Modified Davis grading, without pupil dilation, 45° FOV — 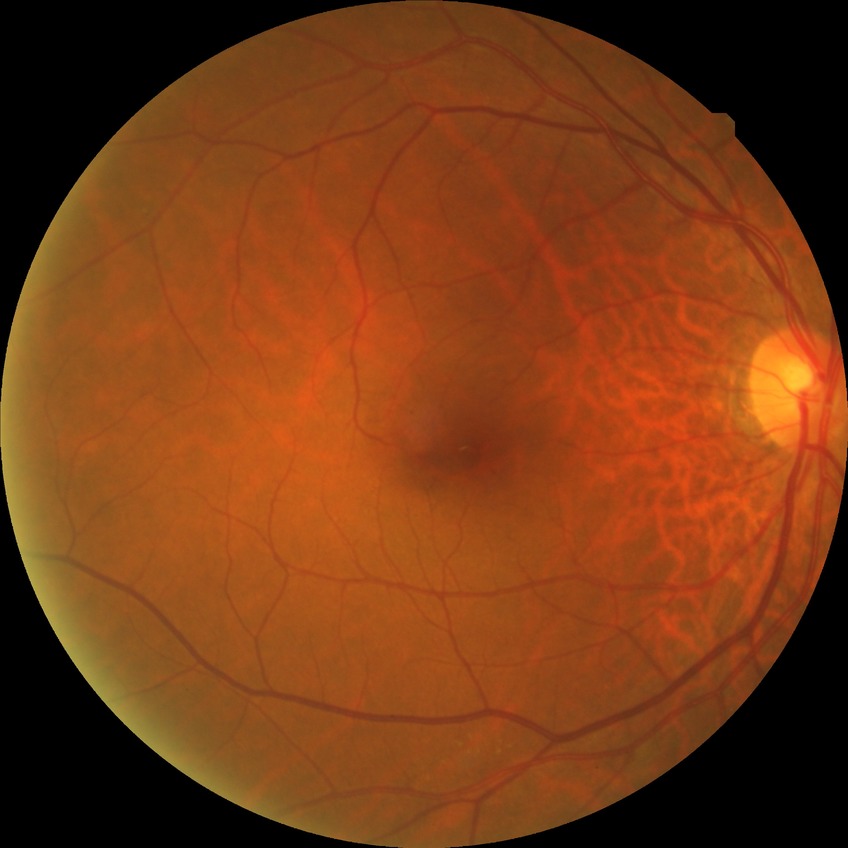
diabetic retinopathy (DR) = NDR (no diabetic retinopathy)